Wide-field fundus image from infant ROP screening; 640 x 480 pixels.
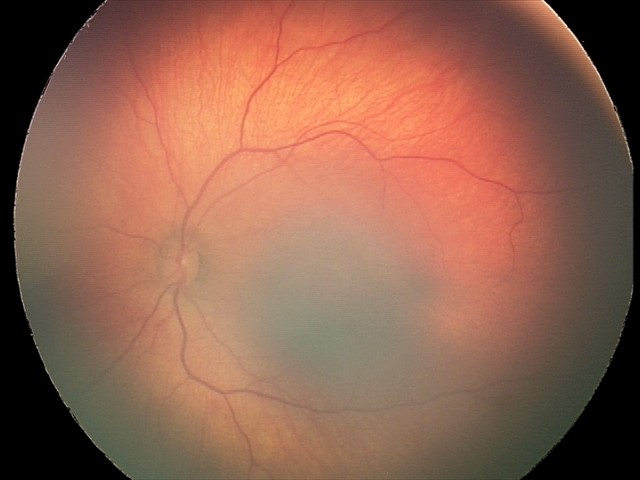 Impression: retinal hemorrhages.